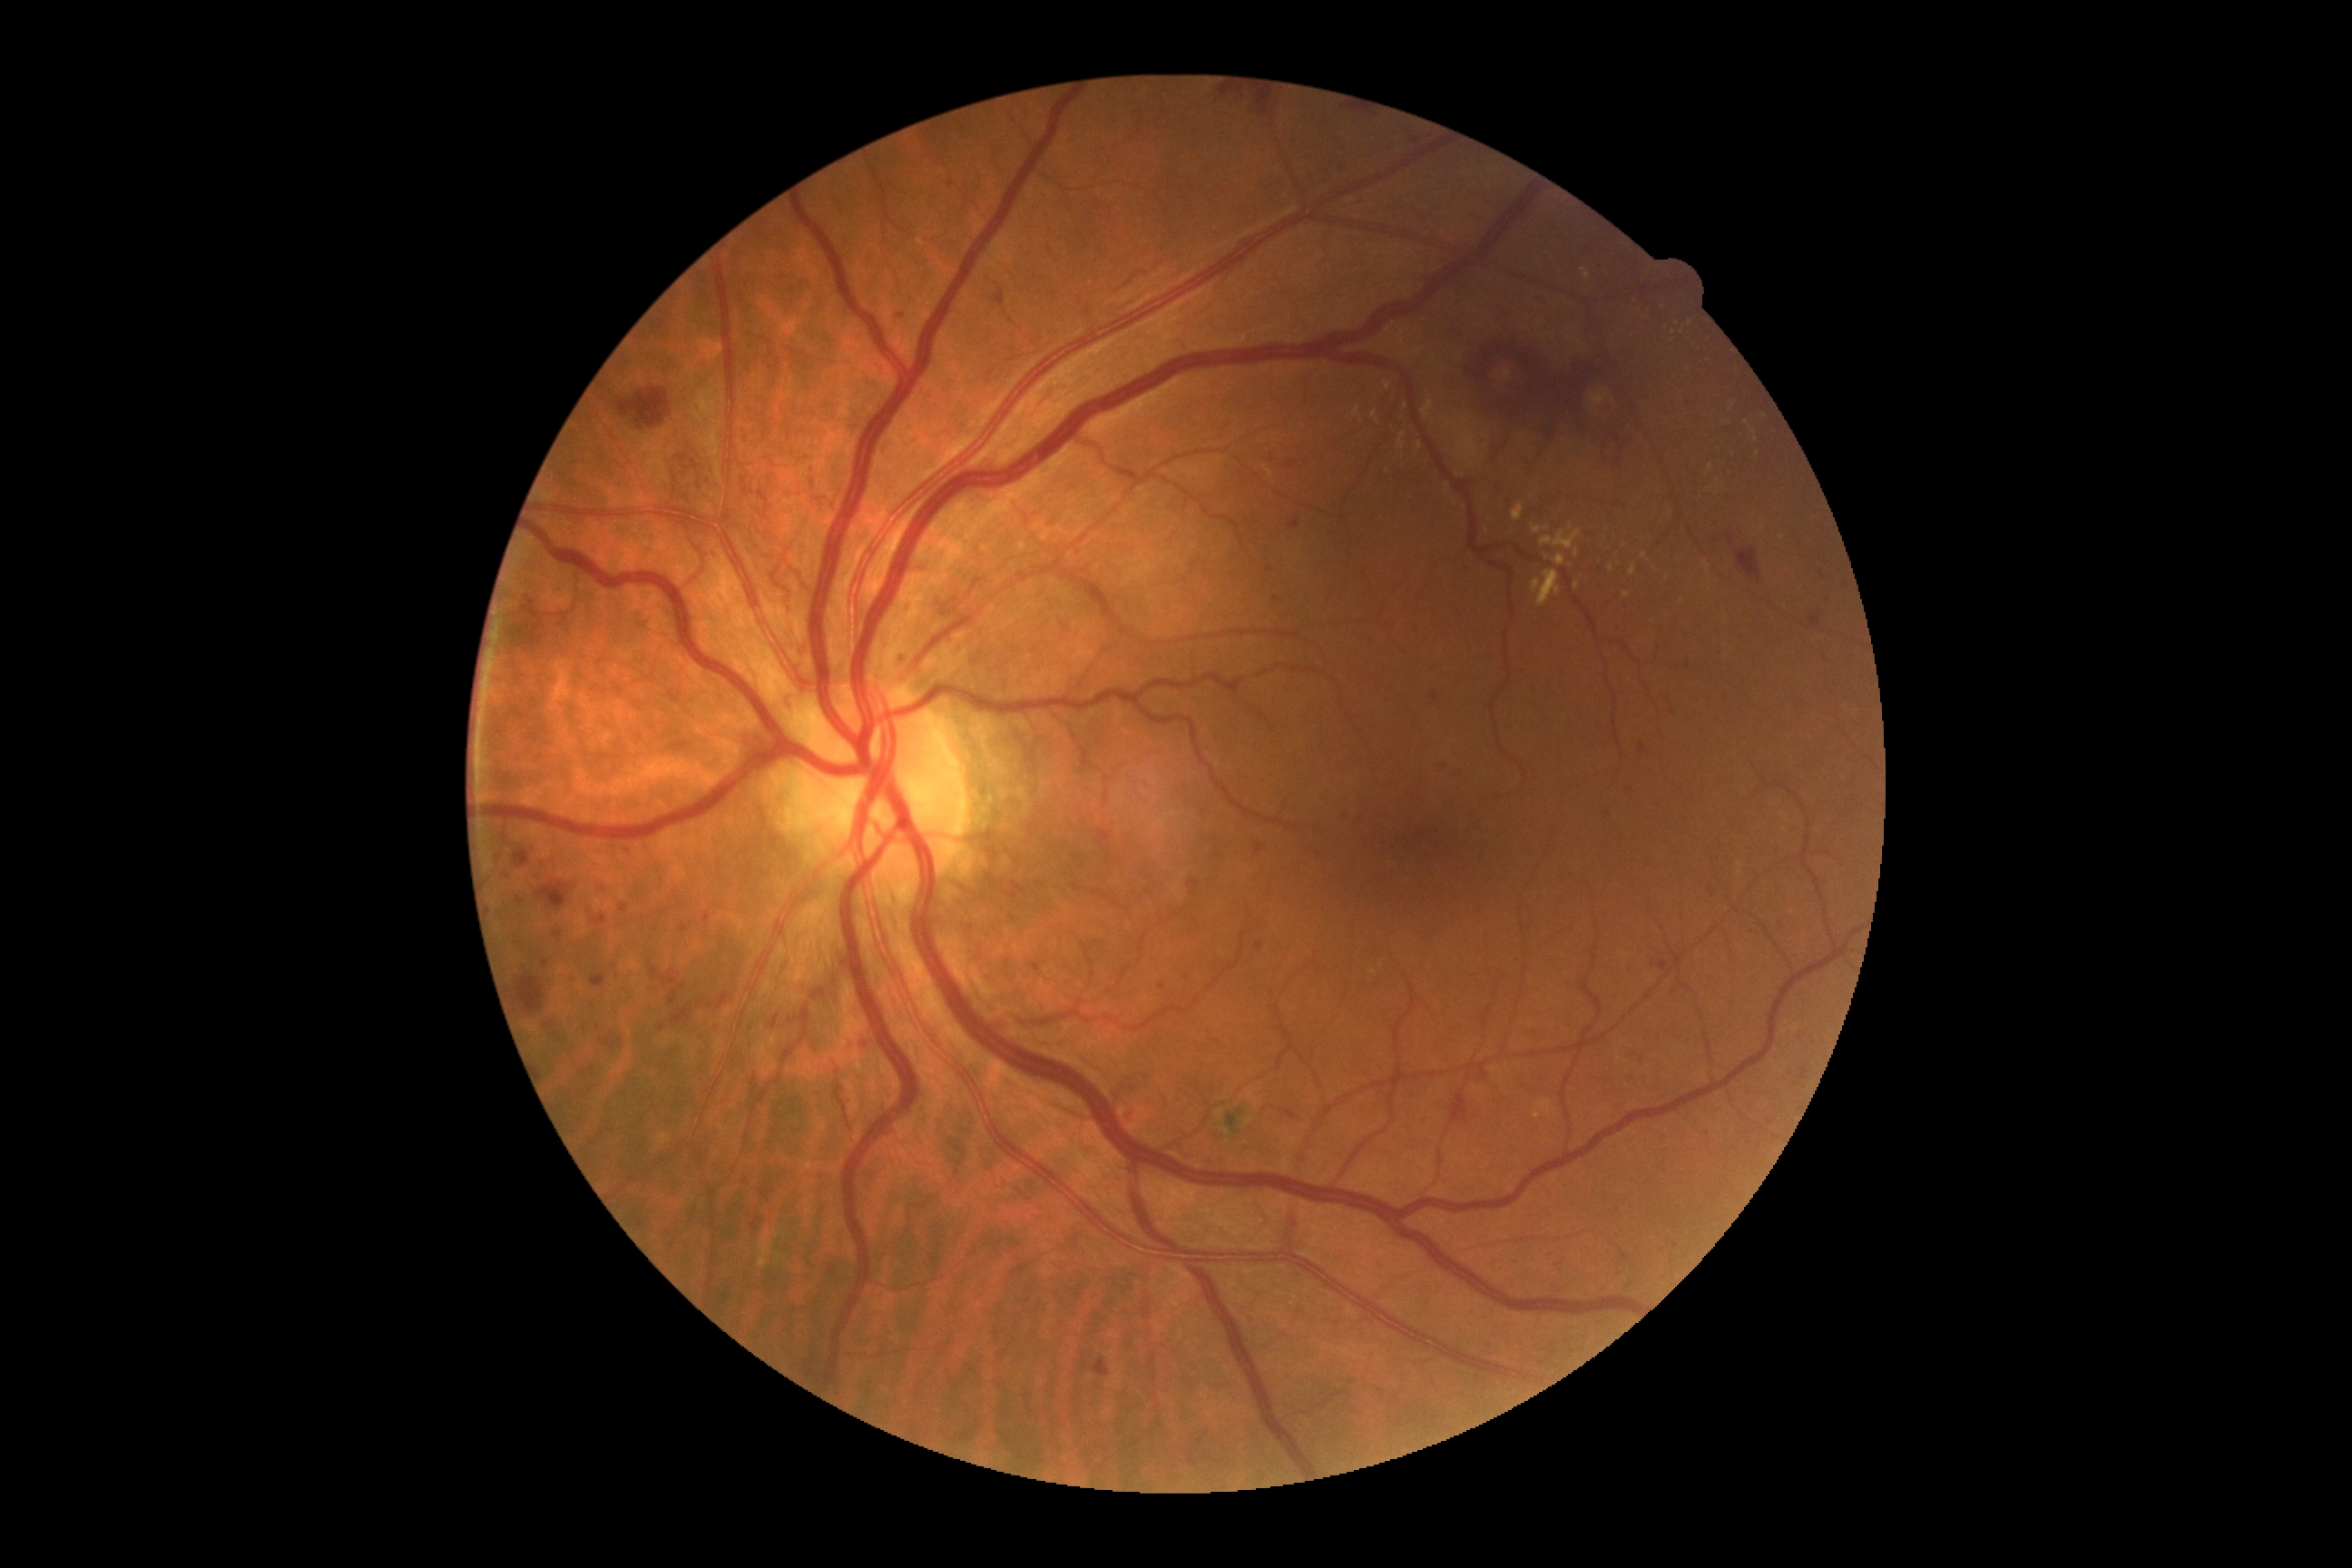 Retinopathy grade is severe NPDR (3).
Microaneurysms are present, including at 516/897/525/905; 705/914/712/923; 614/1043/622/1048; 896/315/906/320; 625/847/634/858; 680/925/689/934; 770/1015/779/1030; 1126/1108/1135/1126.
Additional small microaneurysms near [690,418]; [602,888]; [1674,992]; [1771,1122]; [615,967]; [1629,791]; [1751,933]; [585,1030]; [1260,946].